Graded on the modified Davis scale
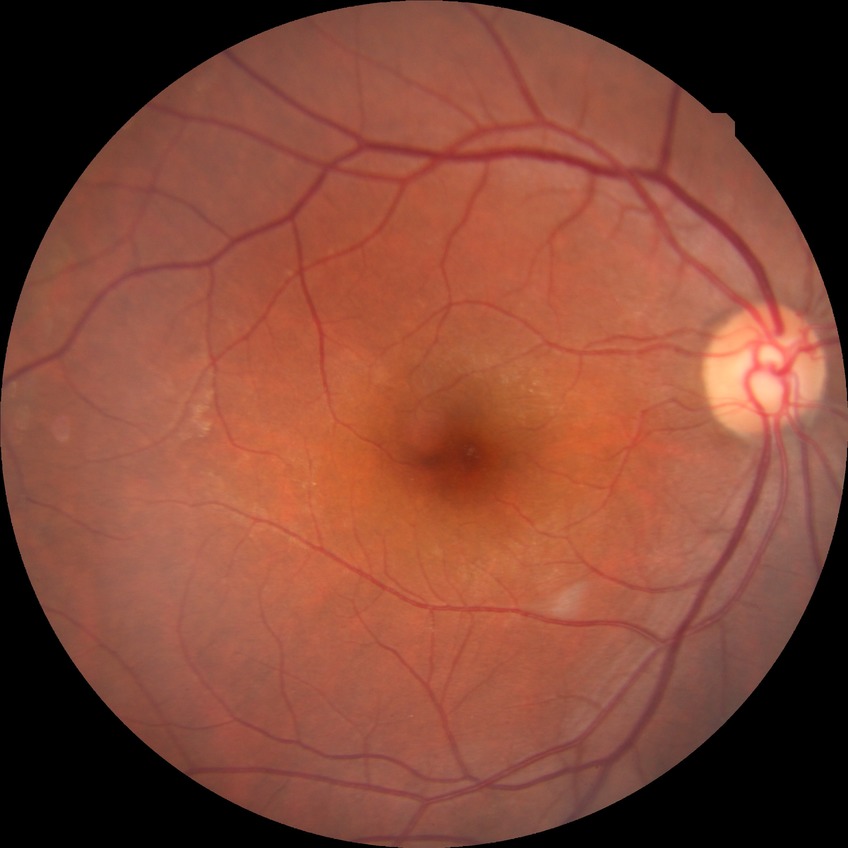 DR impression = no signs of DR, DR severity = NDR.